Intraocular pressure 11 mmHg by non-contact tonometry; acquired with a Topcon TRC-NW400.
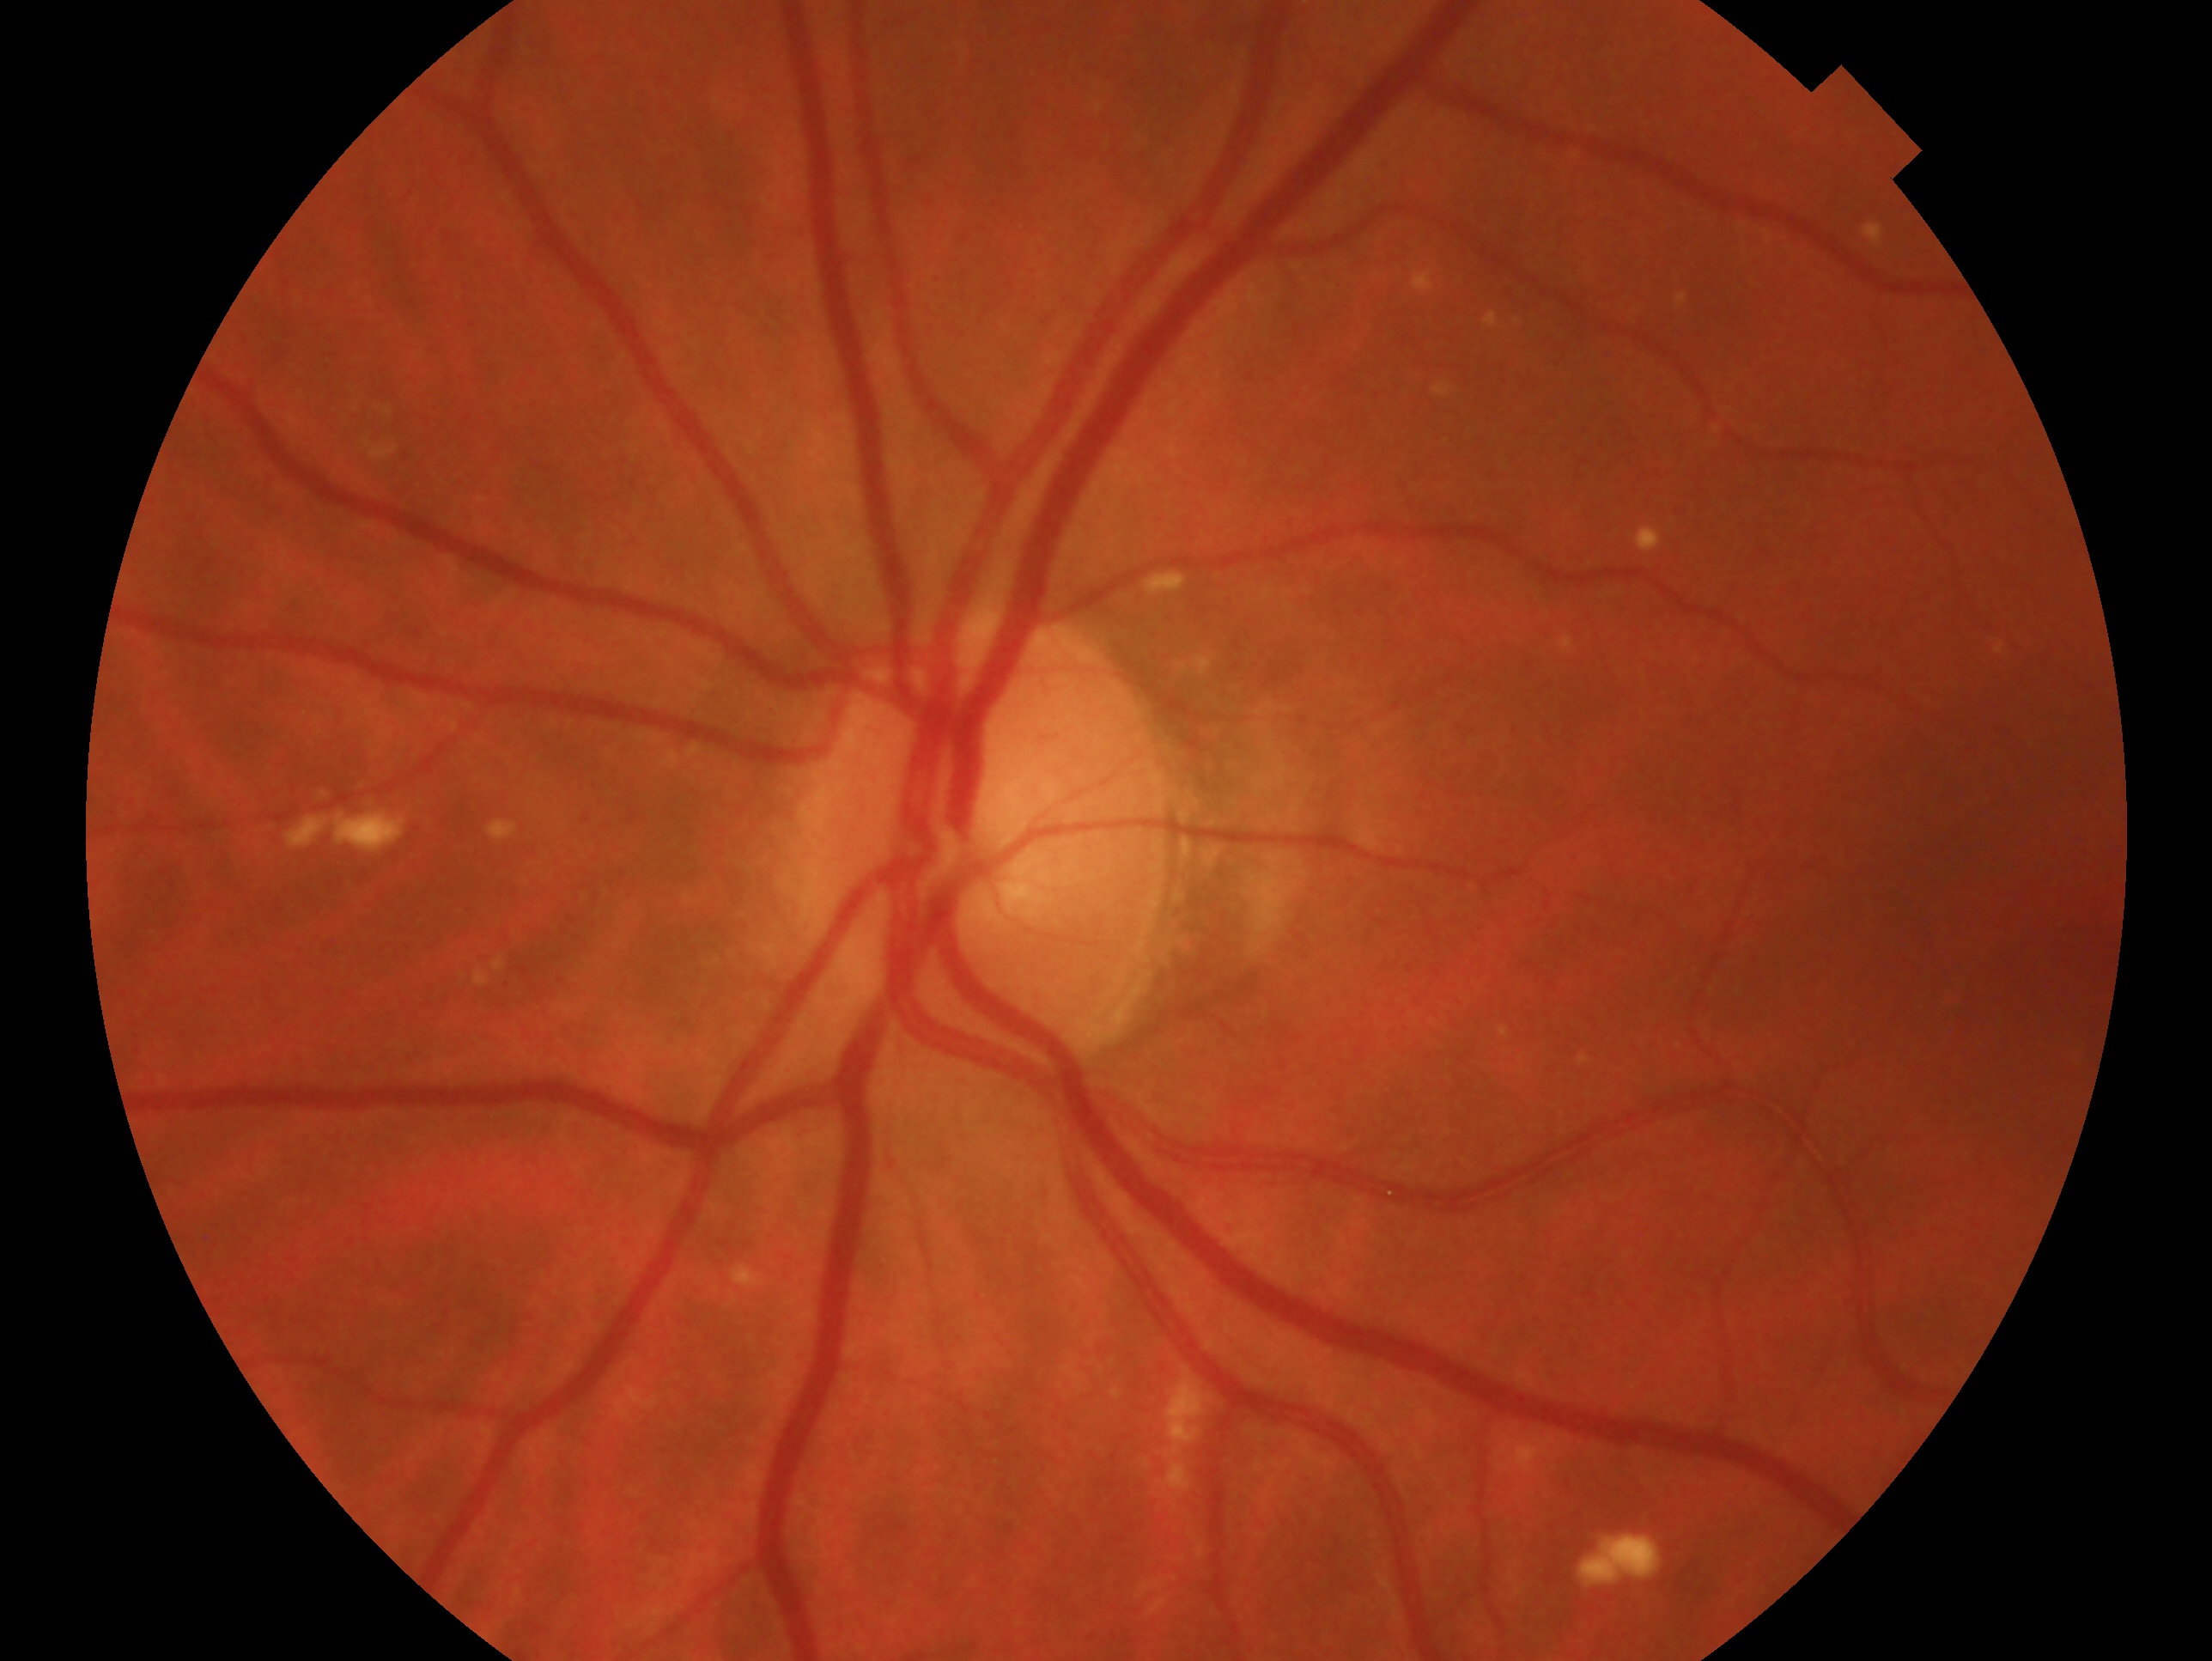

laterality: left eye; assessment: negative for glaucoma.